Retinal fundus photograph
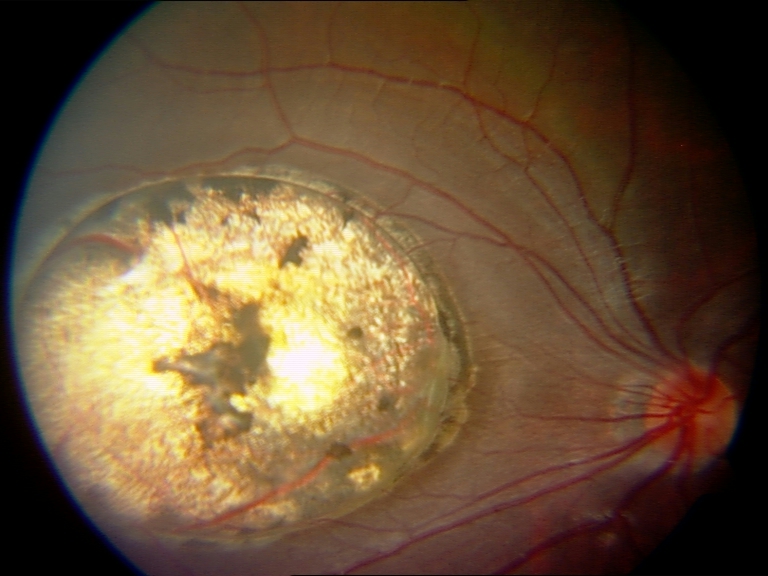 Demonstrates chorioretinal atrophy or coloboma. Features include focal or extensive retinal pigment epithelium and choroidal atrophy or coloboma.